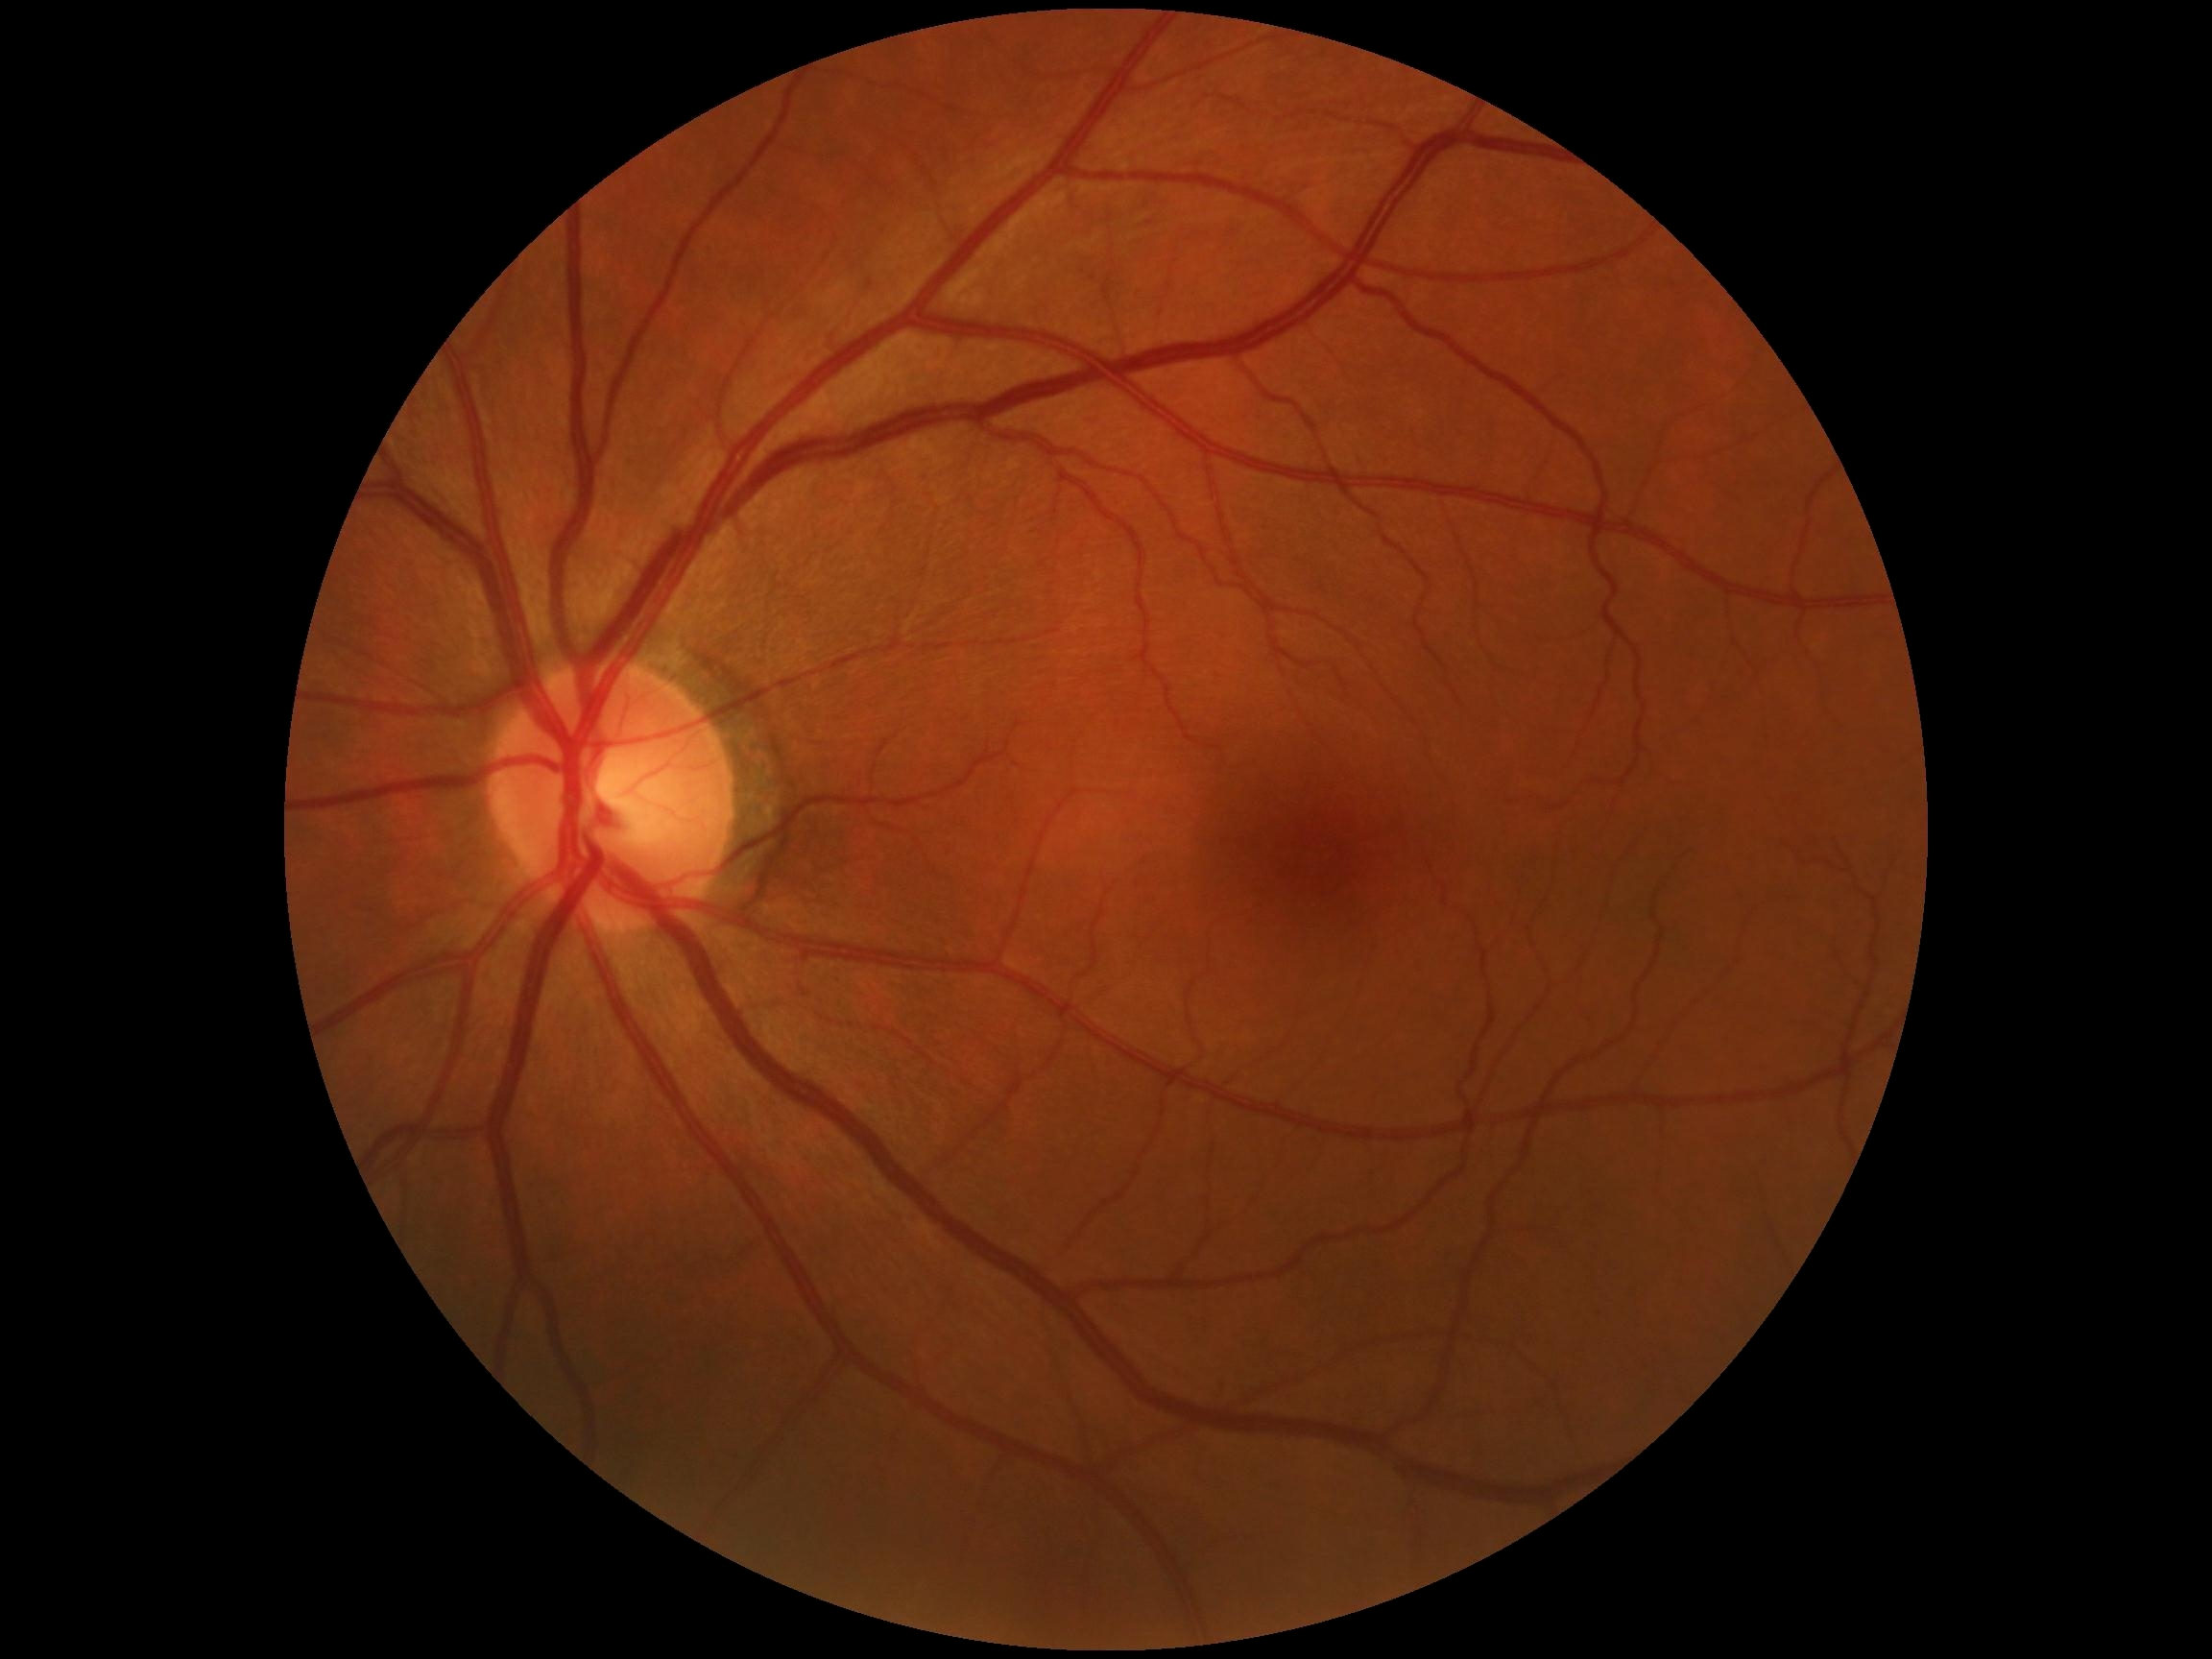

  dr_impression: no apparent DR
  dr_grade: 0